Retinal fundus photograph.
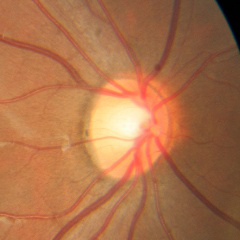 Findings consistent with no glaucomatous optic neuropathy.